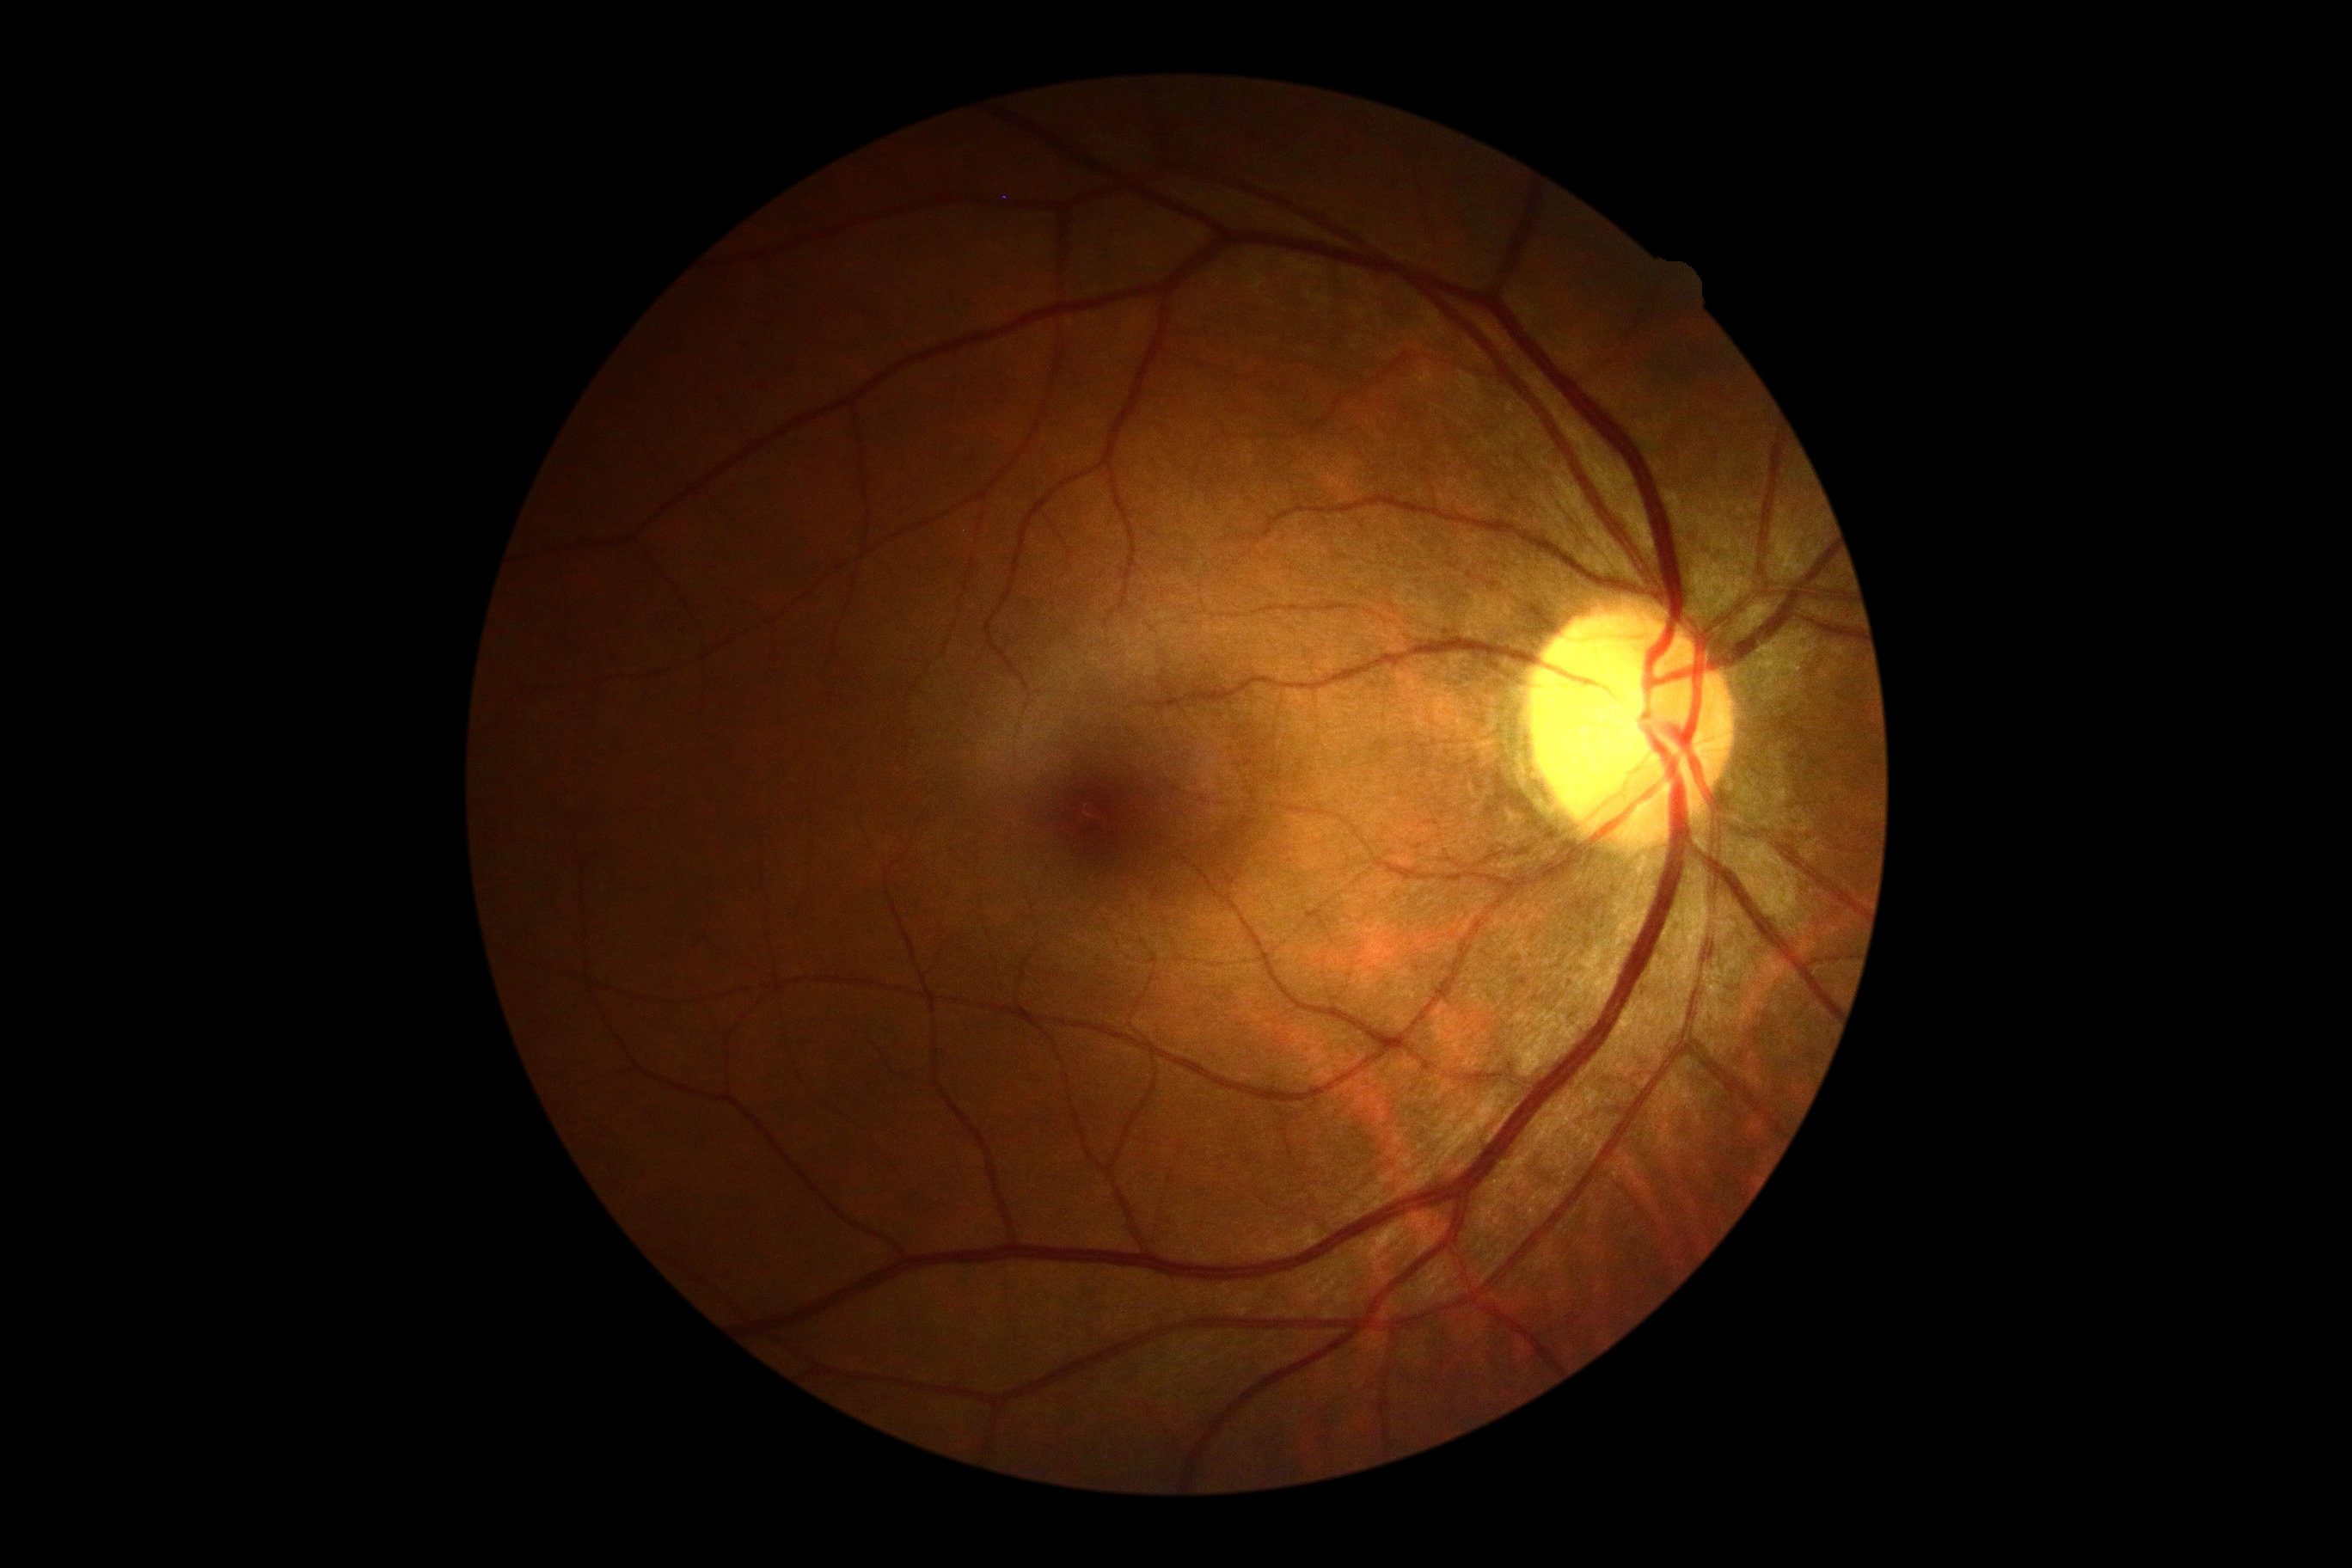

{"dr_grade": "grade 0 (no apparent retinopathy)"}